FOV: 45 degrees · fundus photo — 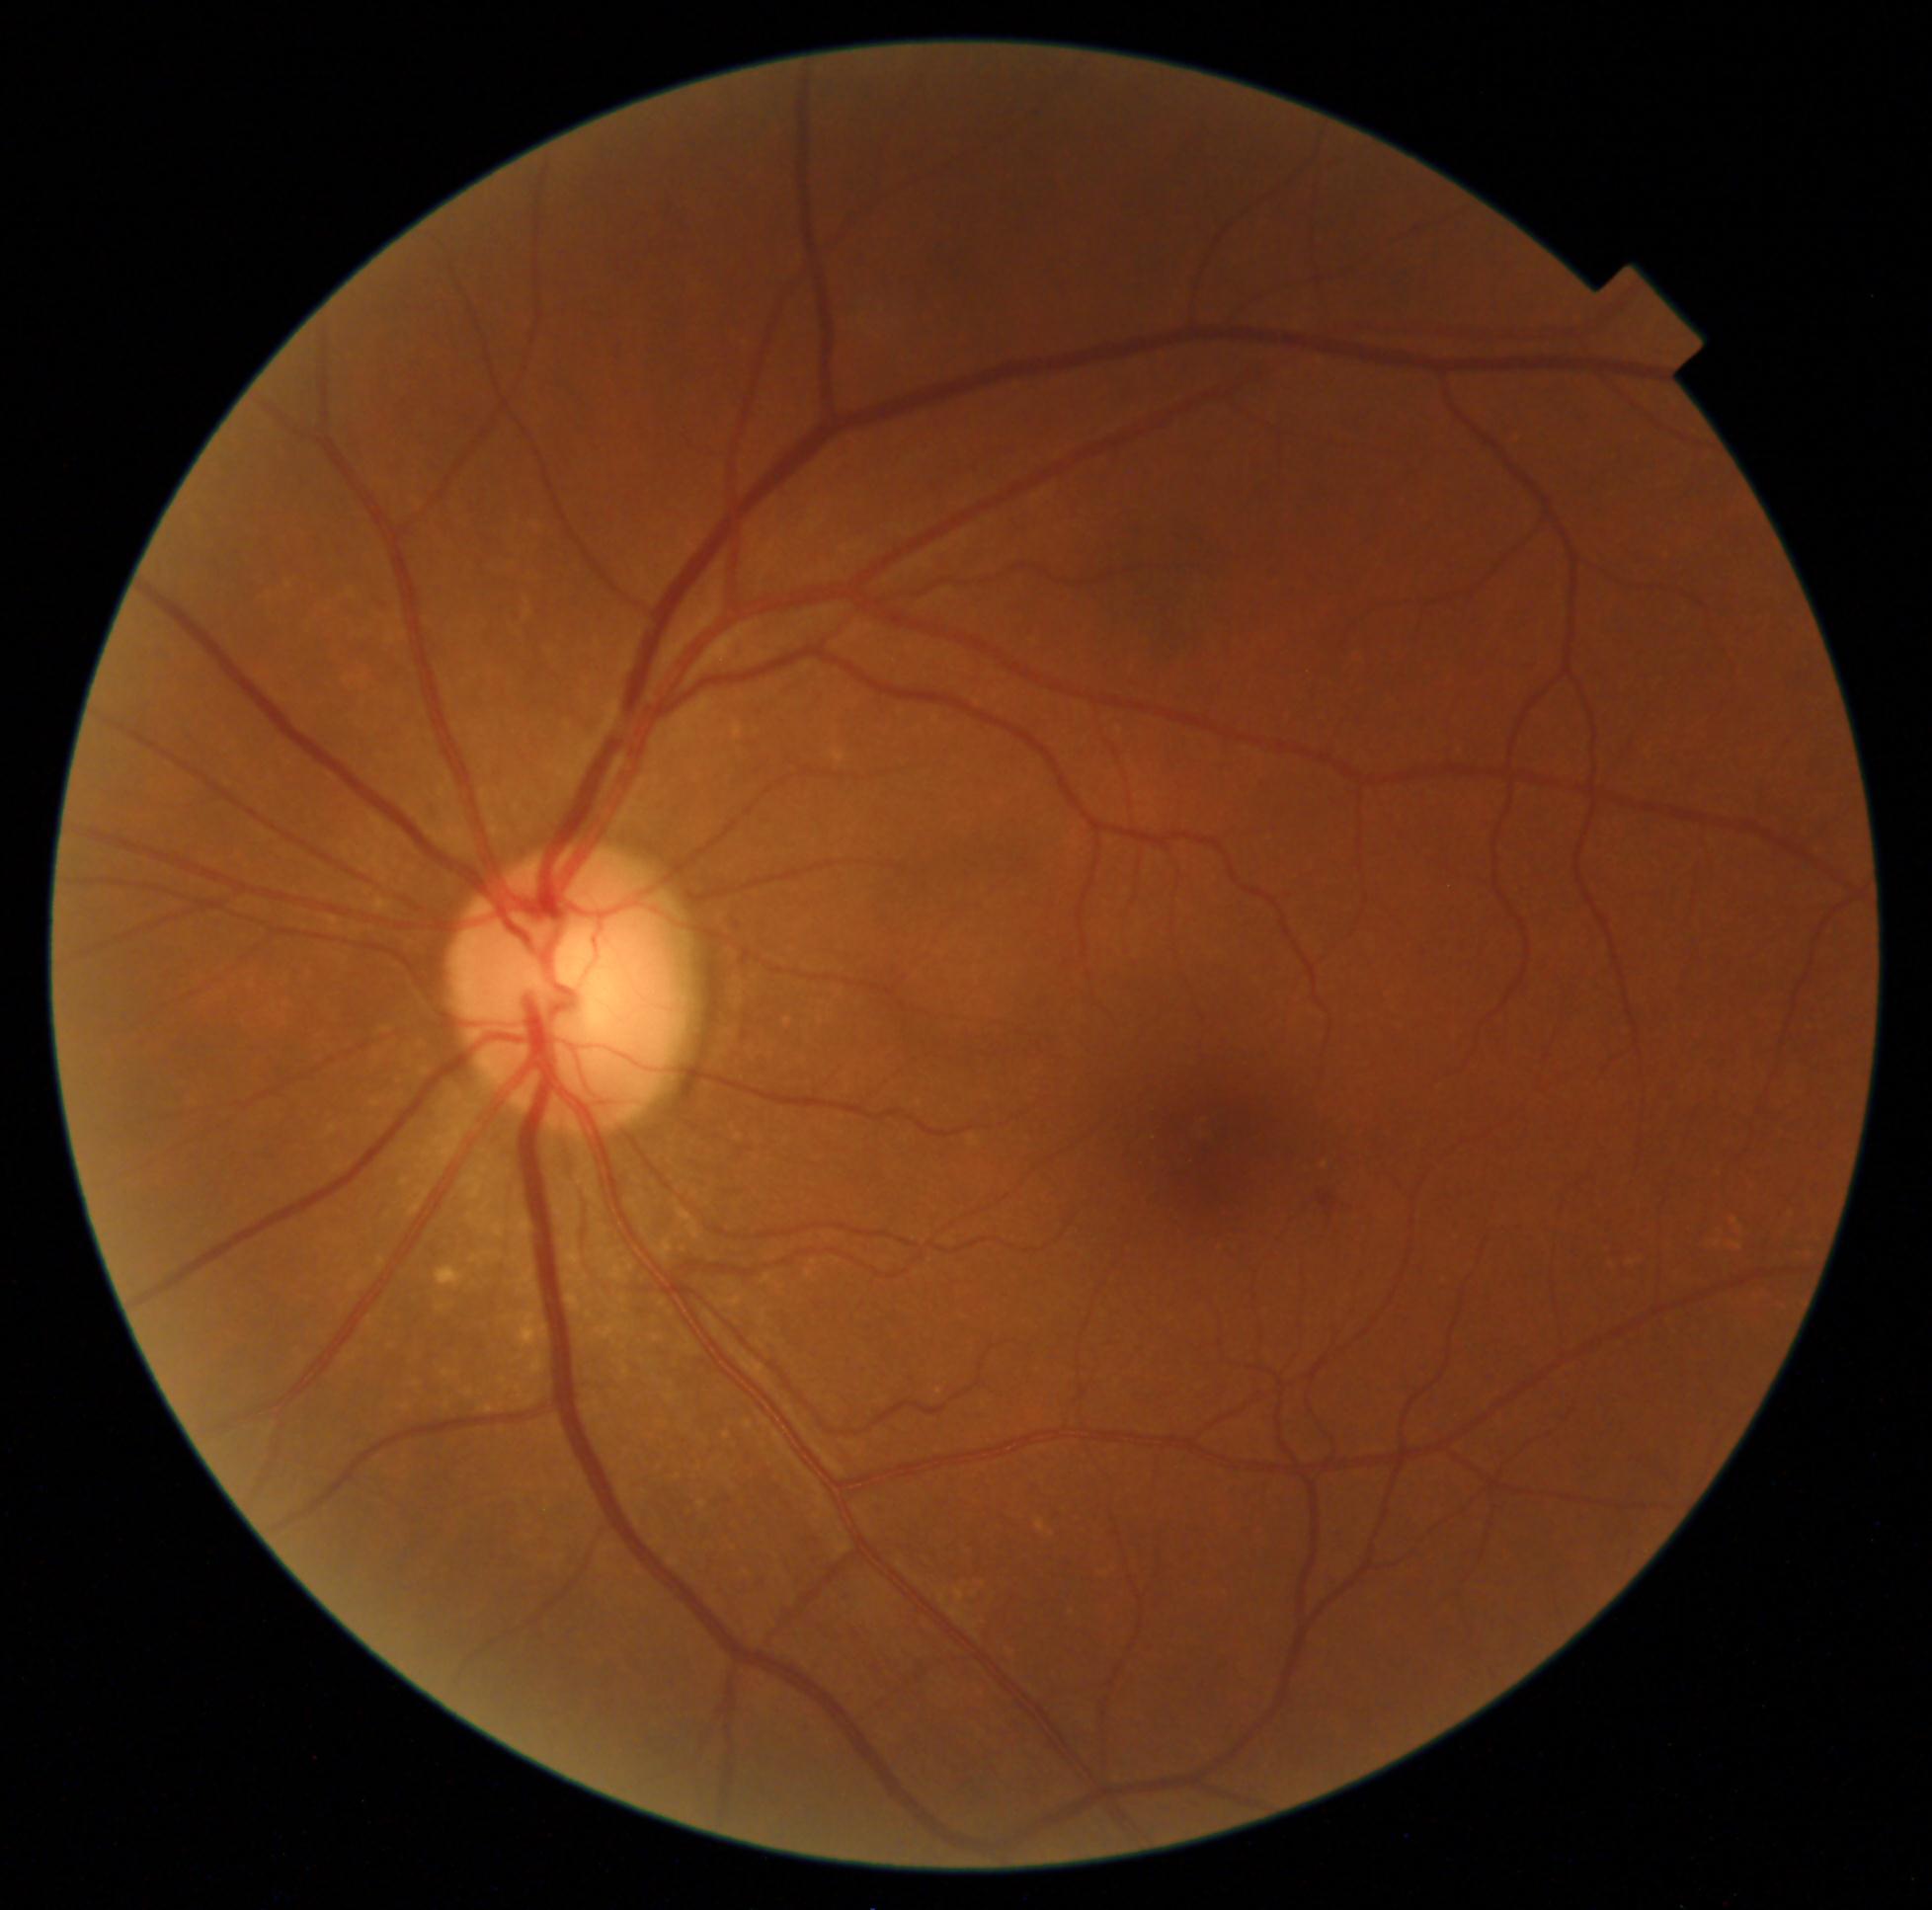

Diabetic retinopathy severity is grade 2 (moderate NPDR) — more than just microaneurysms but less than severe NPDR; non-proliferative diabetic retinopathy
microaneurysms: absent
hard exudates: absent
hemorrhages: left=1318, top=1192, right=1337, bottom=1210
soft exudates: absent